848 x 848 pixels:
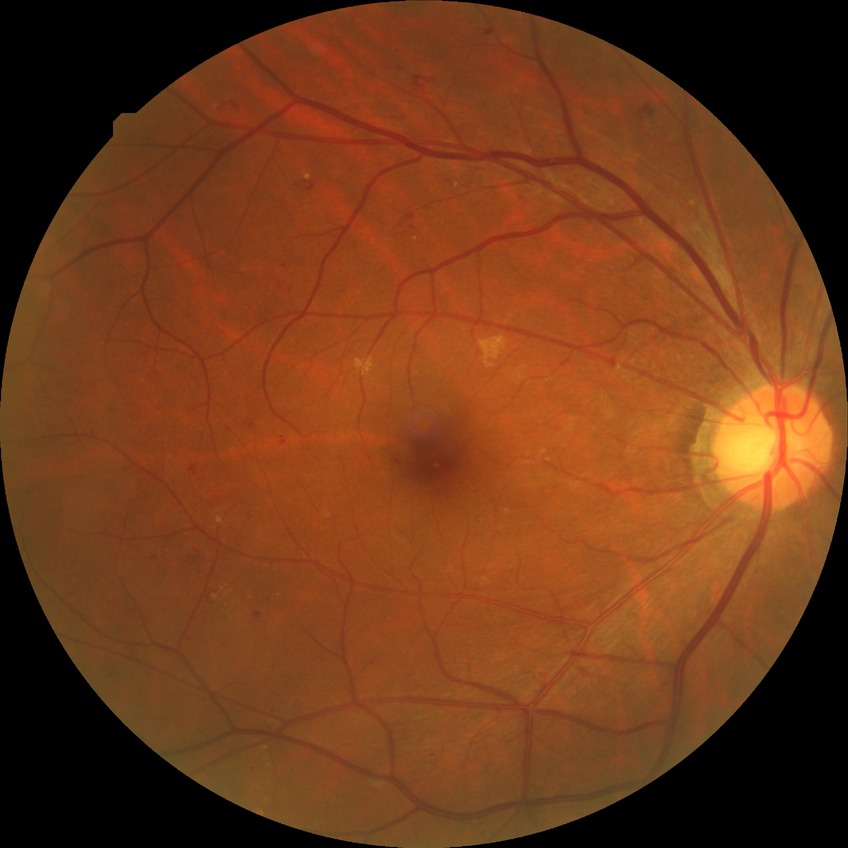
Davis grade is SDR.